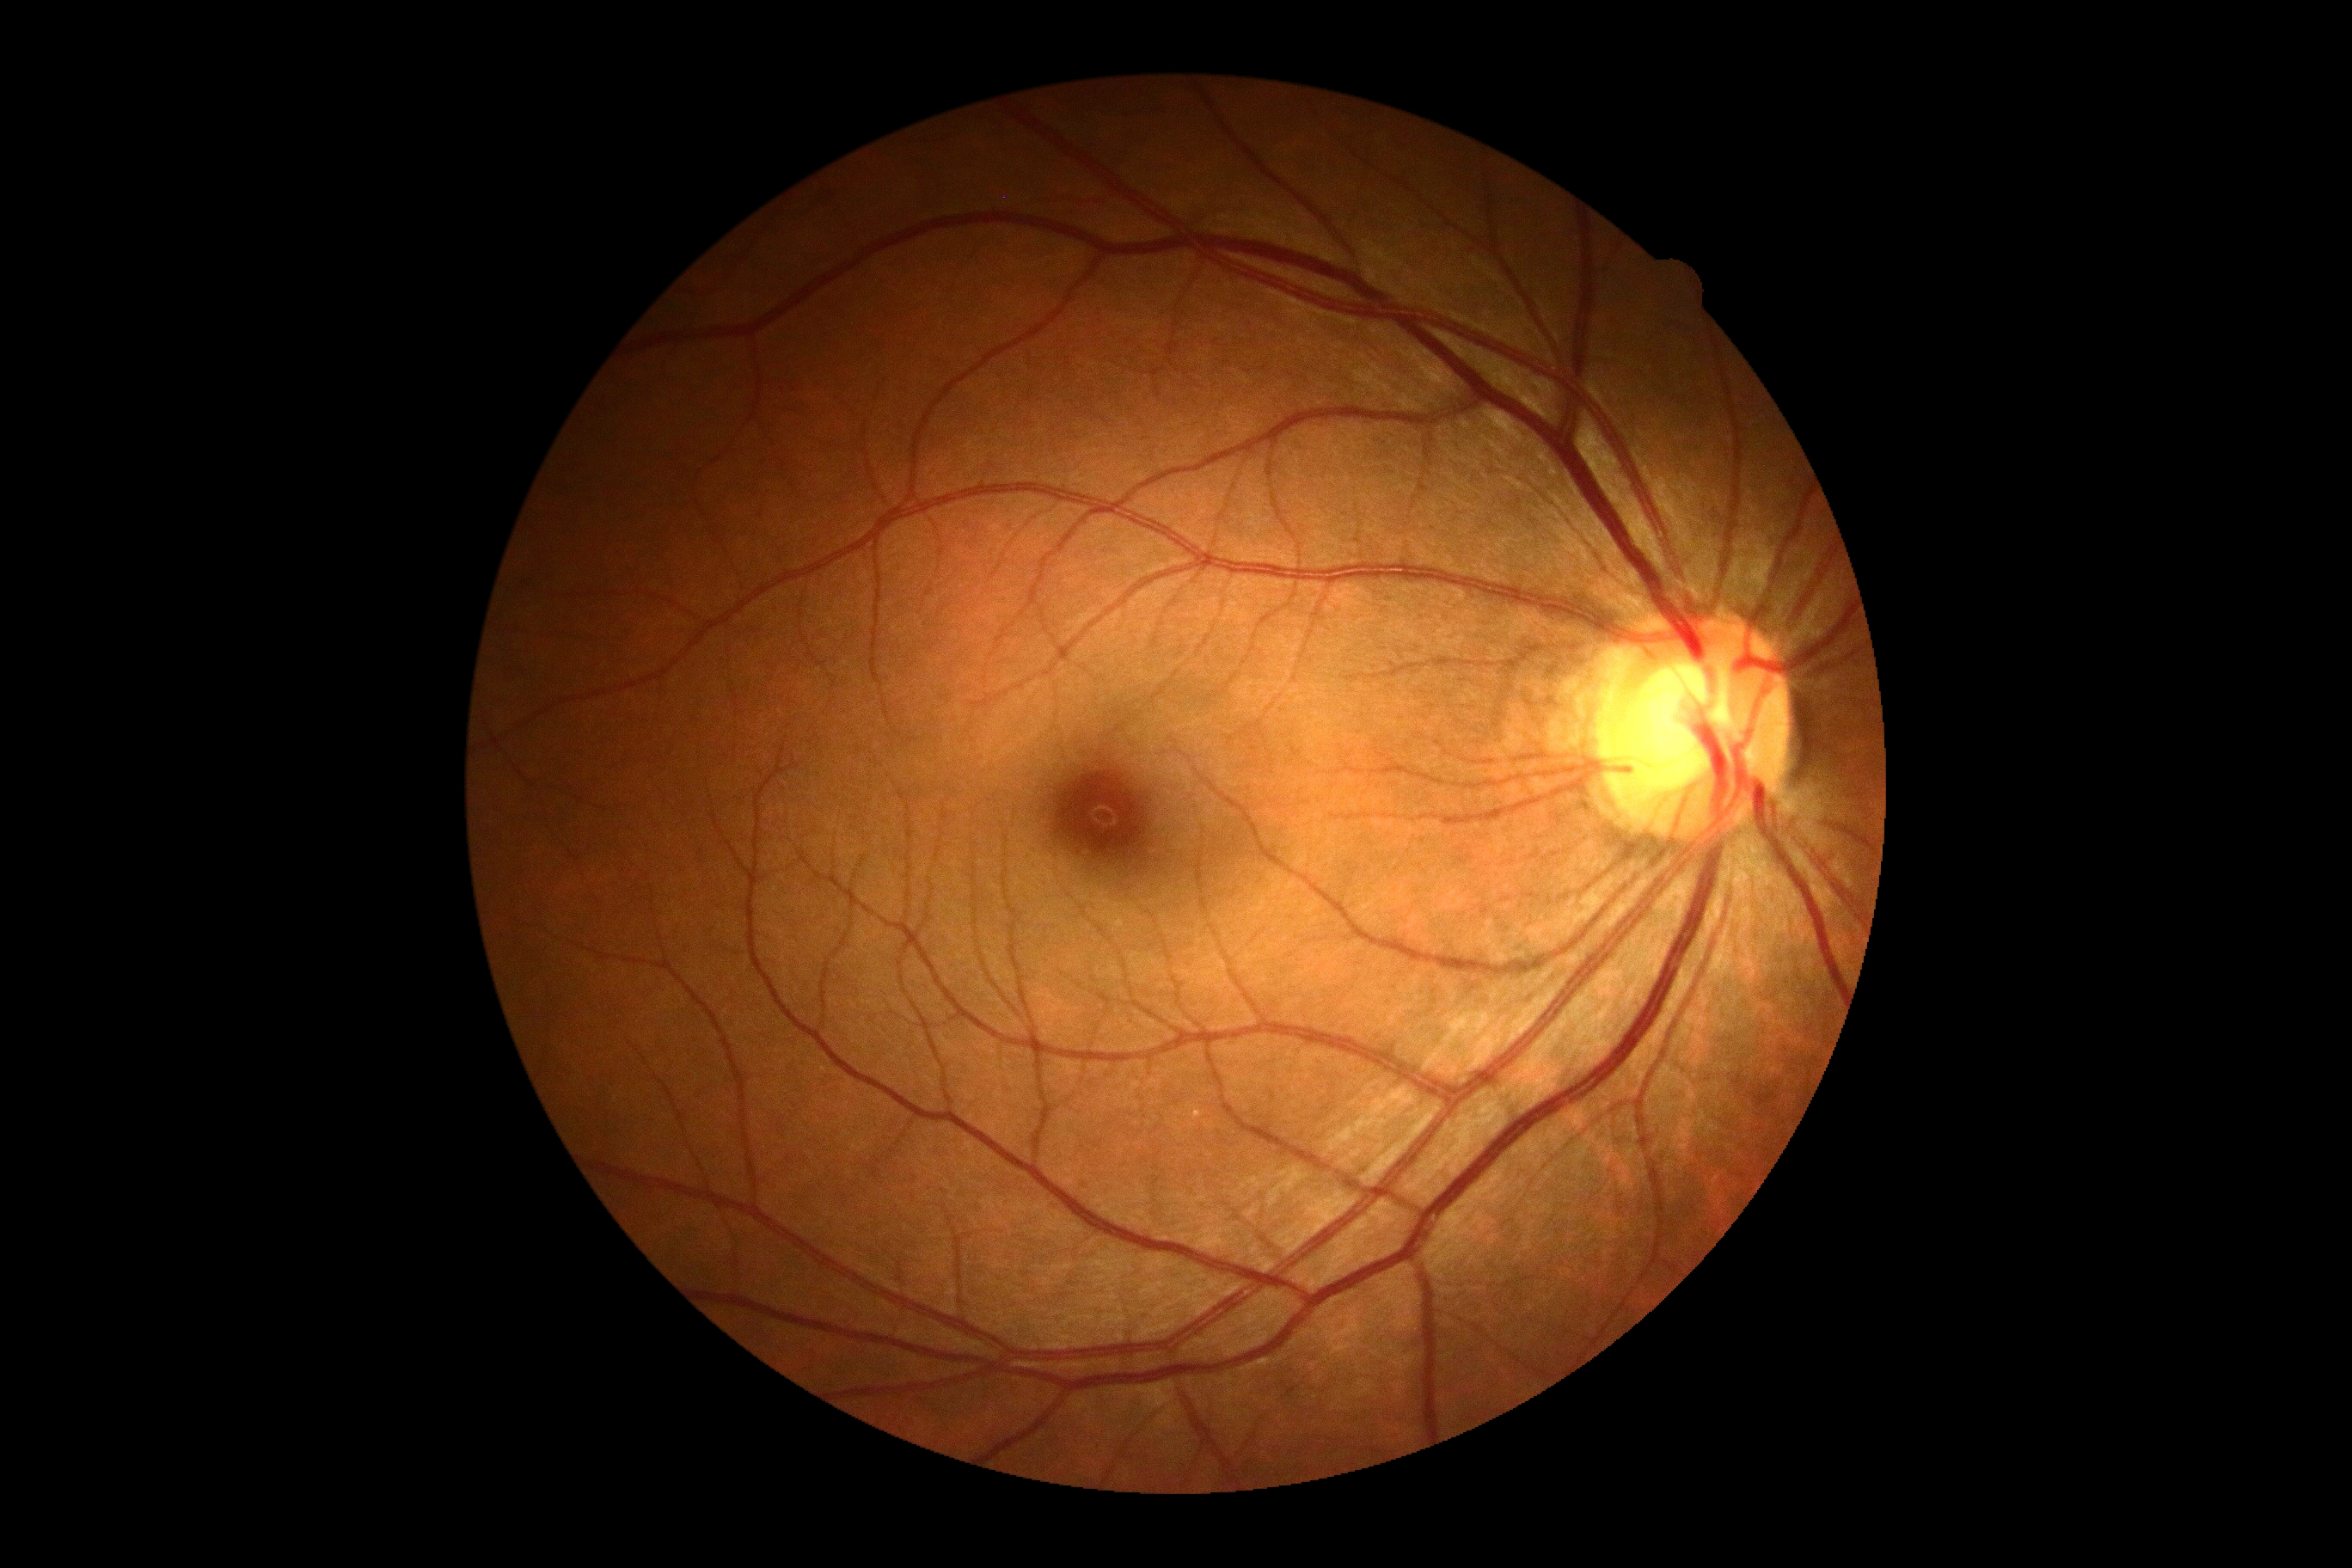
DR grade: 0/4.